Fundus photo — 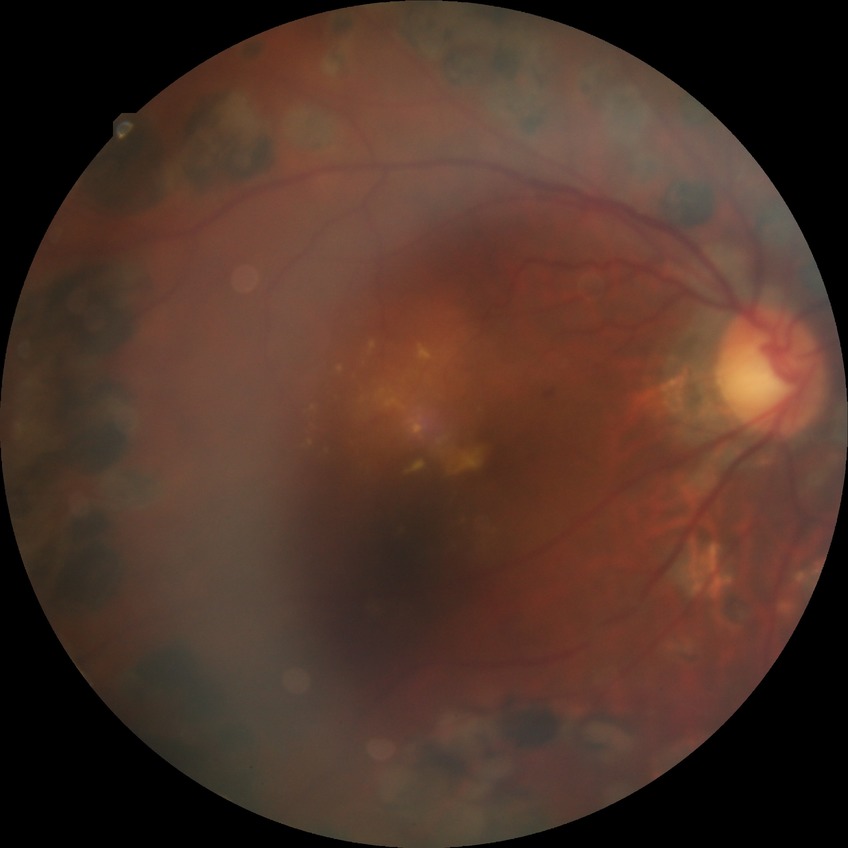

DR stage is PDR.